1932x1923 — 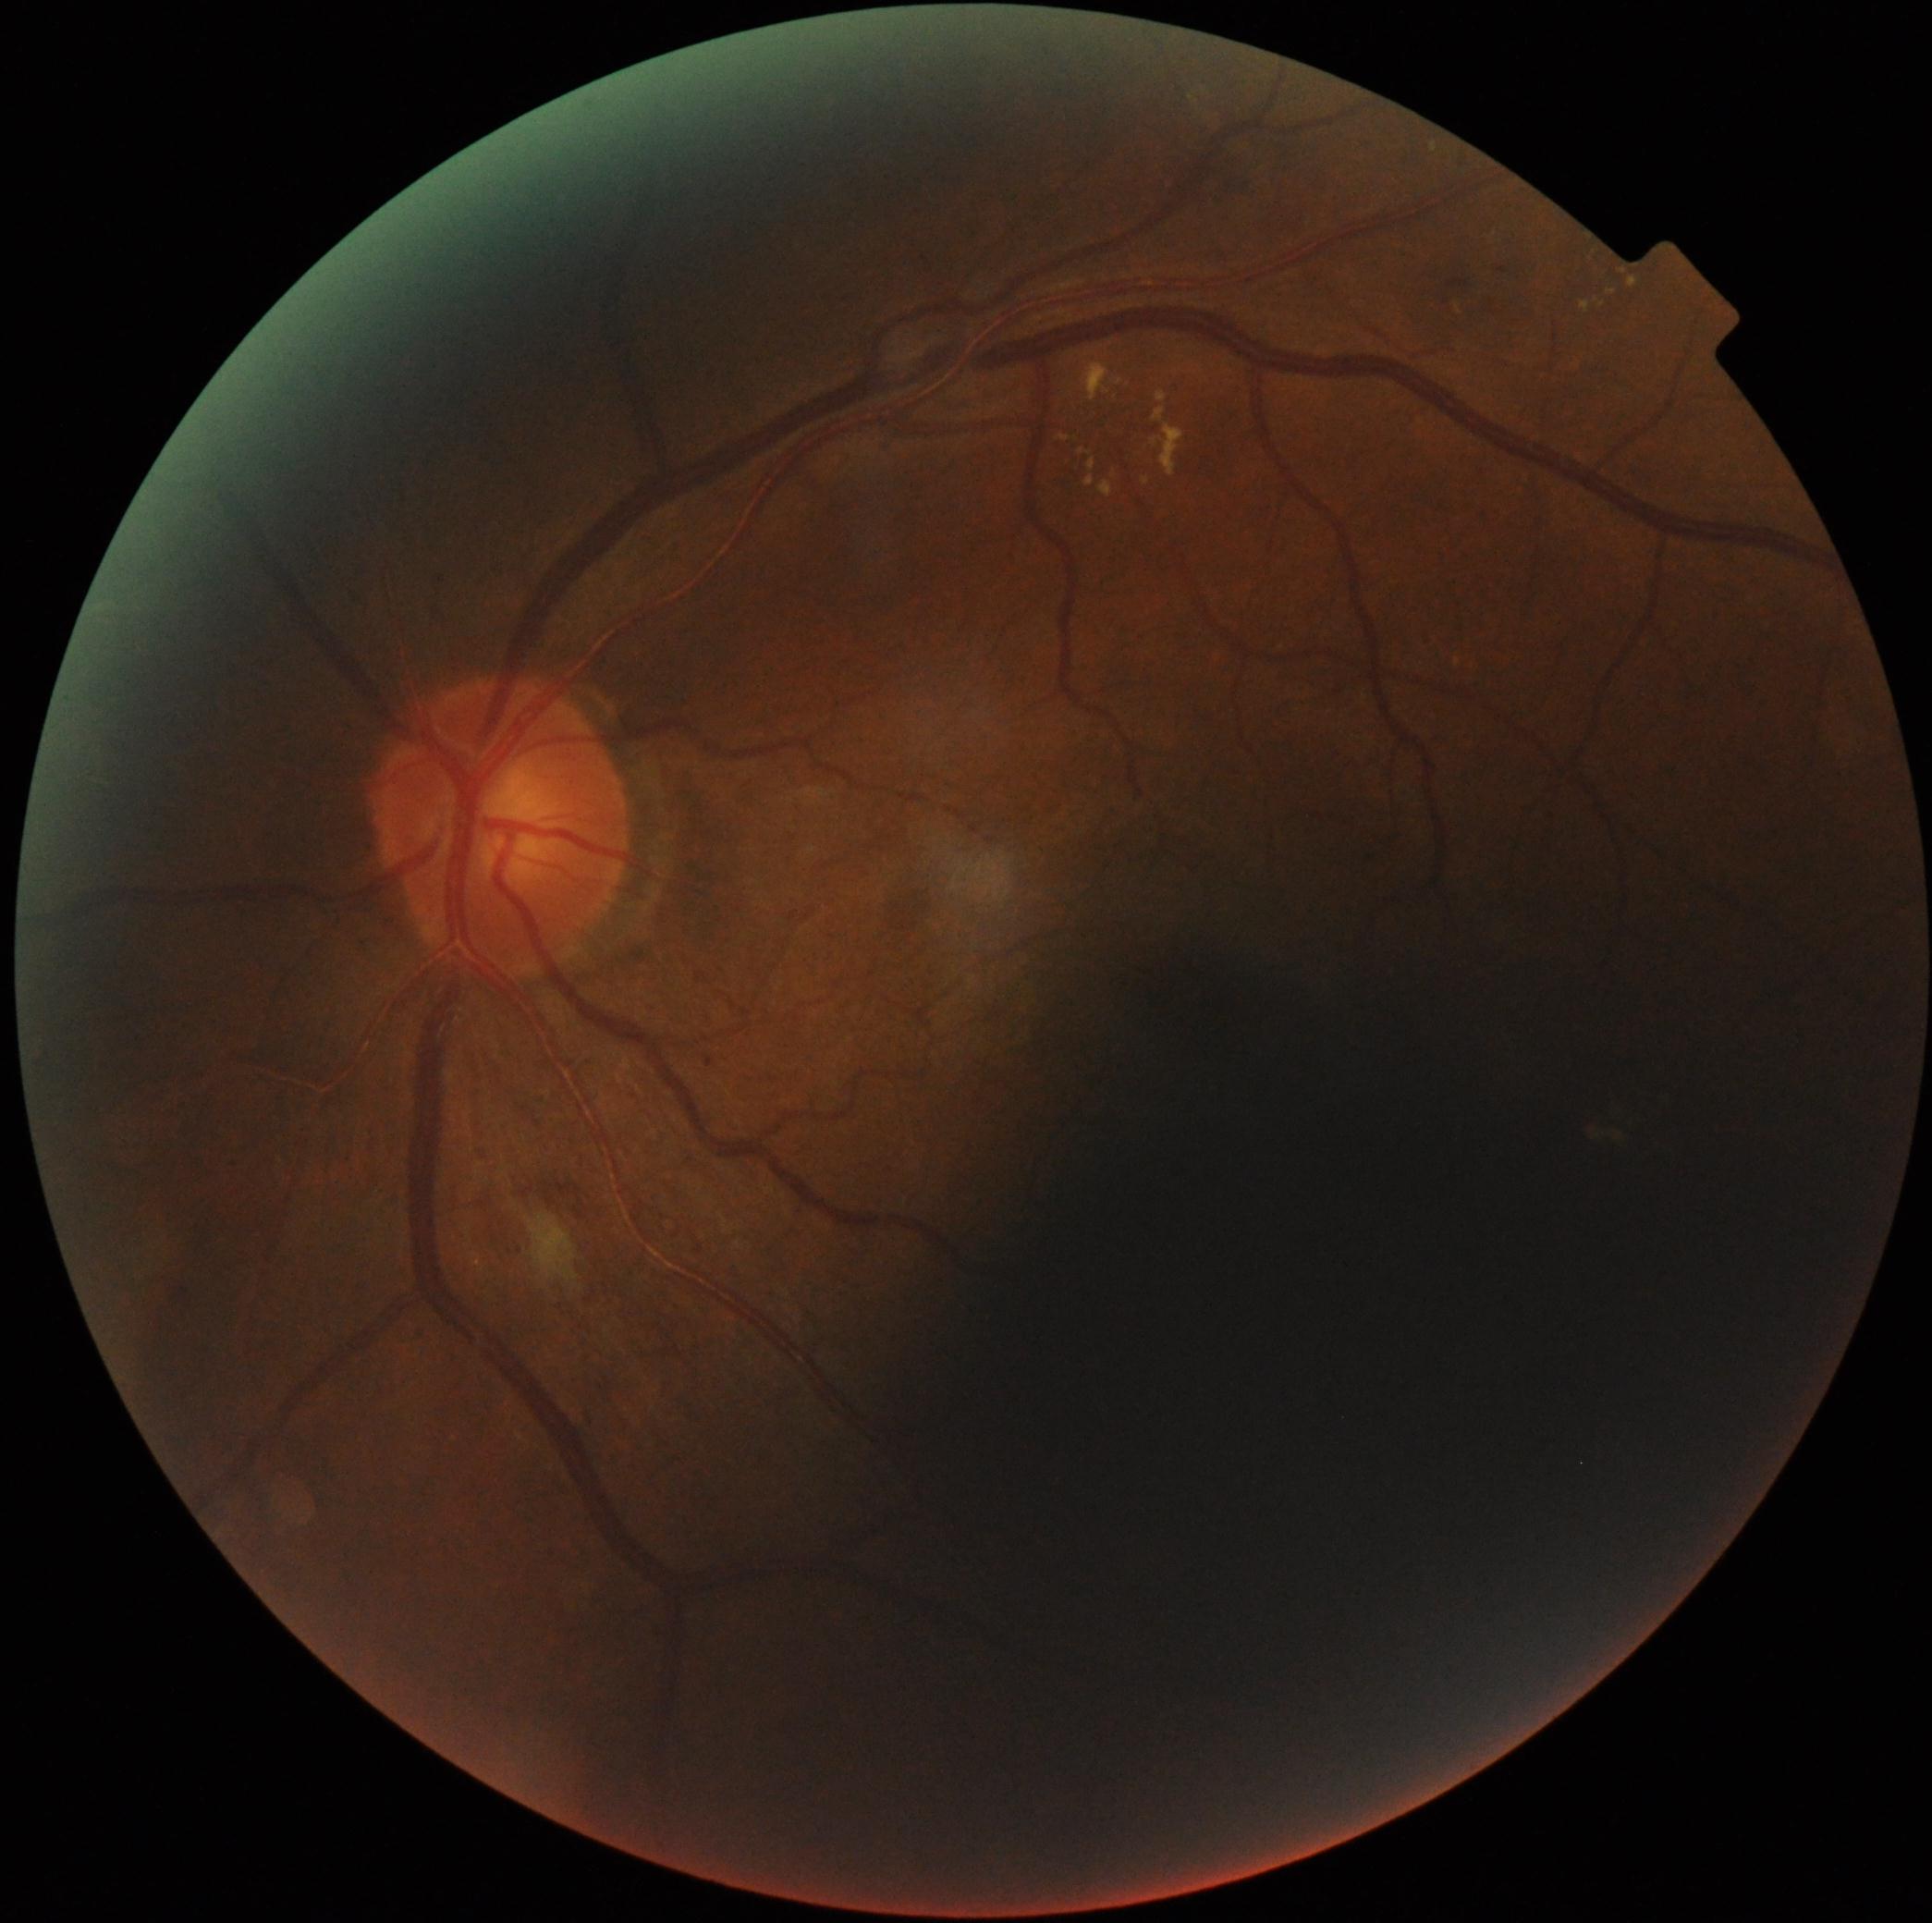

DR grade is 2 (moderate NPDR).